Acquired with a Kowa VX-10α, mydriatic (tropicamide 0.5%)
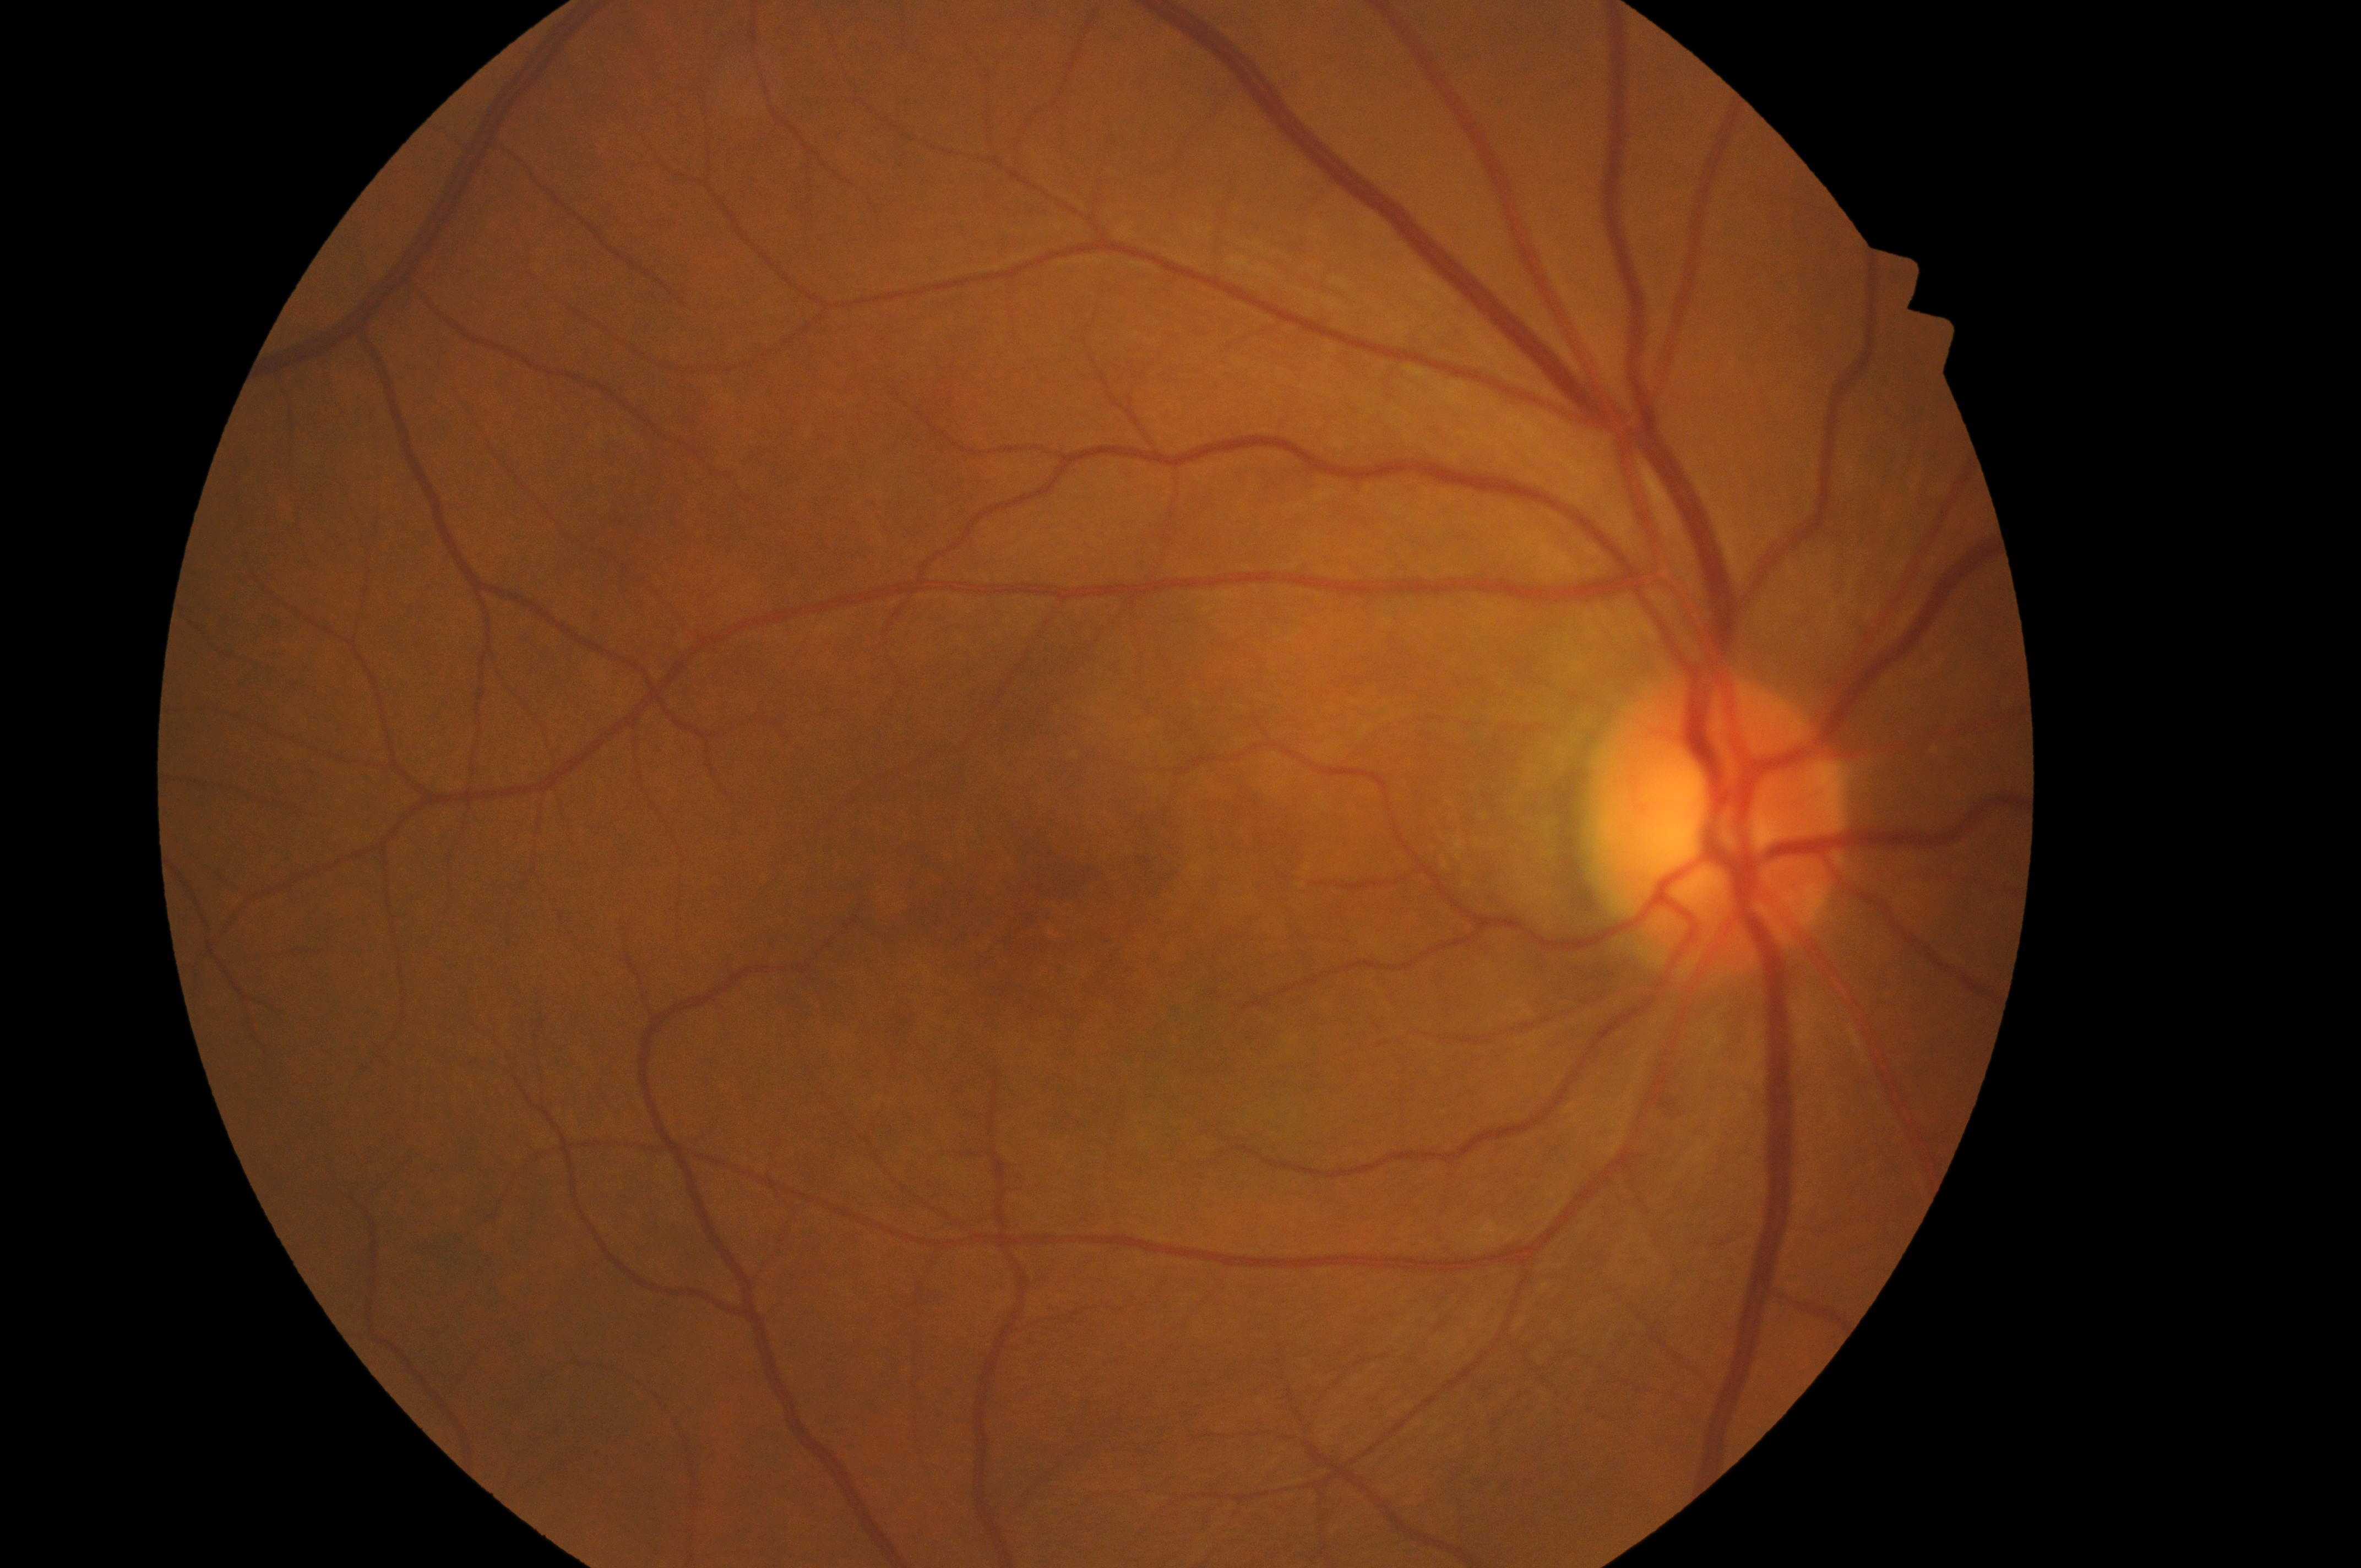
| feature | annotation |
|---|---|
| diabetic retinopathy grade | 0 — no visible signs of diabetic retinopathy |
| fovea | [1052, 907] |
| risk of diabetic macular edema | 0 — no apparent hard exudates |
| the optic disc | [1716, 835] |
| DR impression | No diabetic retinal disease findings |
| laterality | the right eye |